Fundus photo. Without pupil dilation. Graded on the modified Davis scale. NIDEK AFC-230 fundus camera. 45-degree field of view: 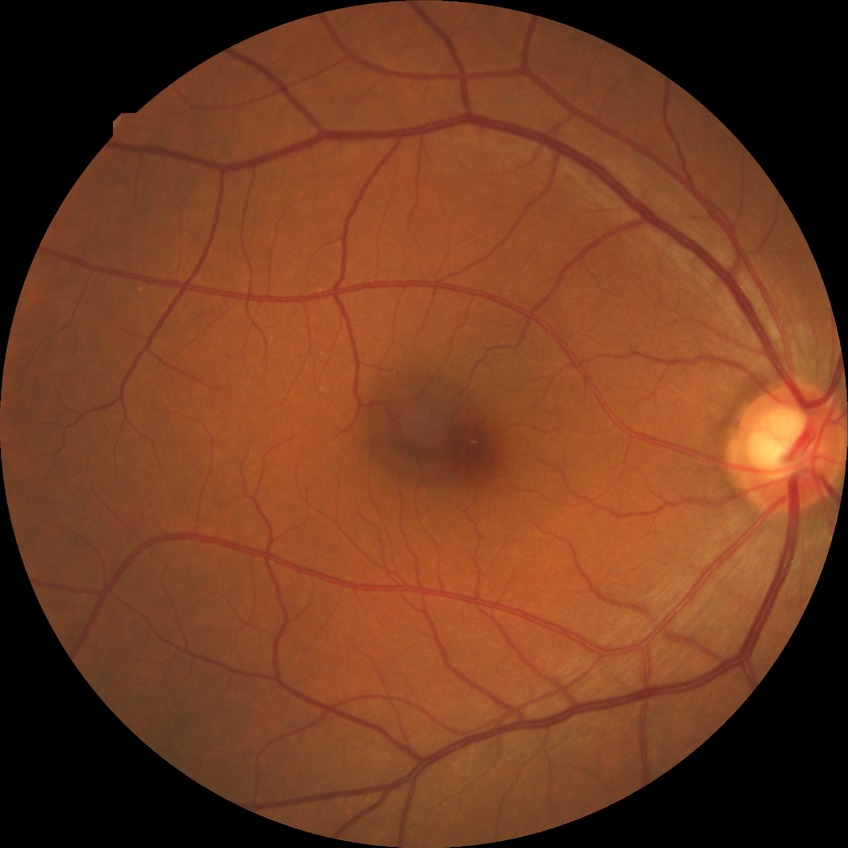 Diabetic retinopathy (DR): no diabetic retinopathy (NDR).